50° field of view — 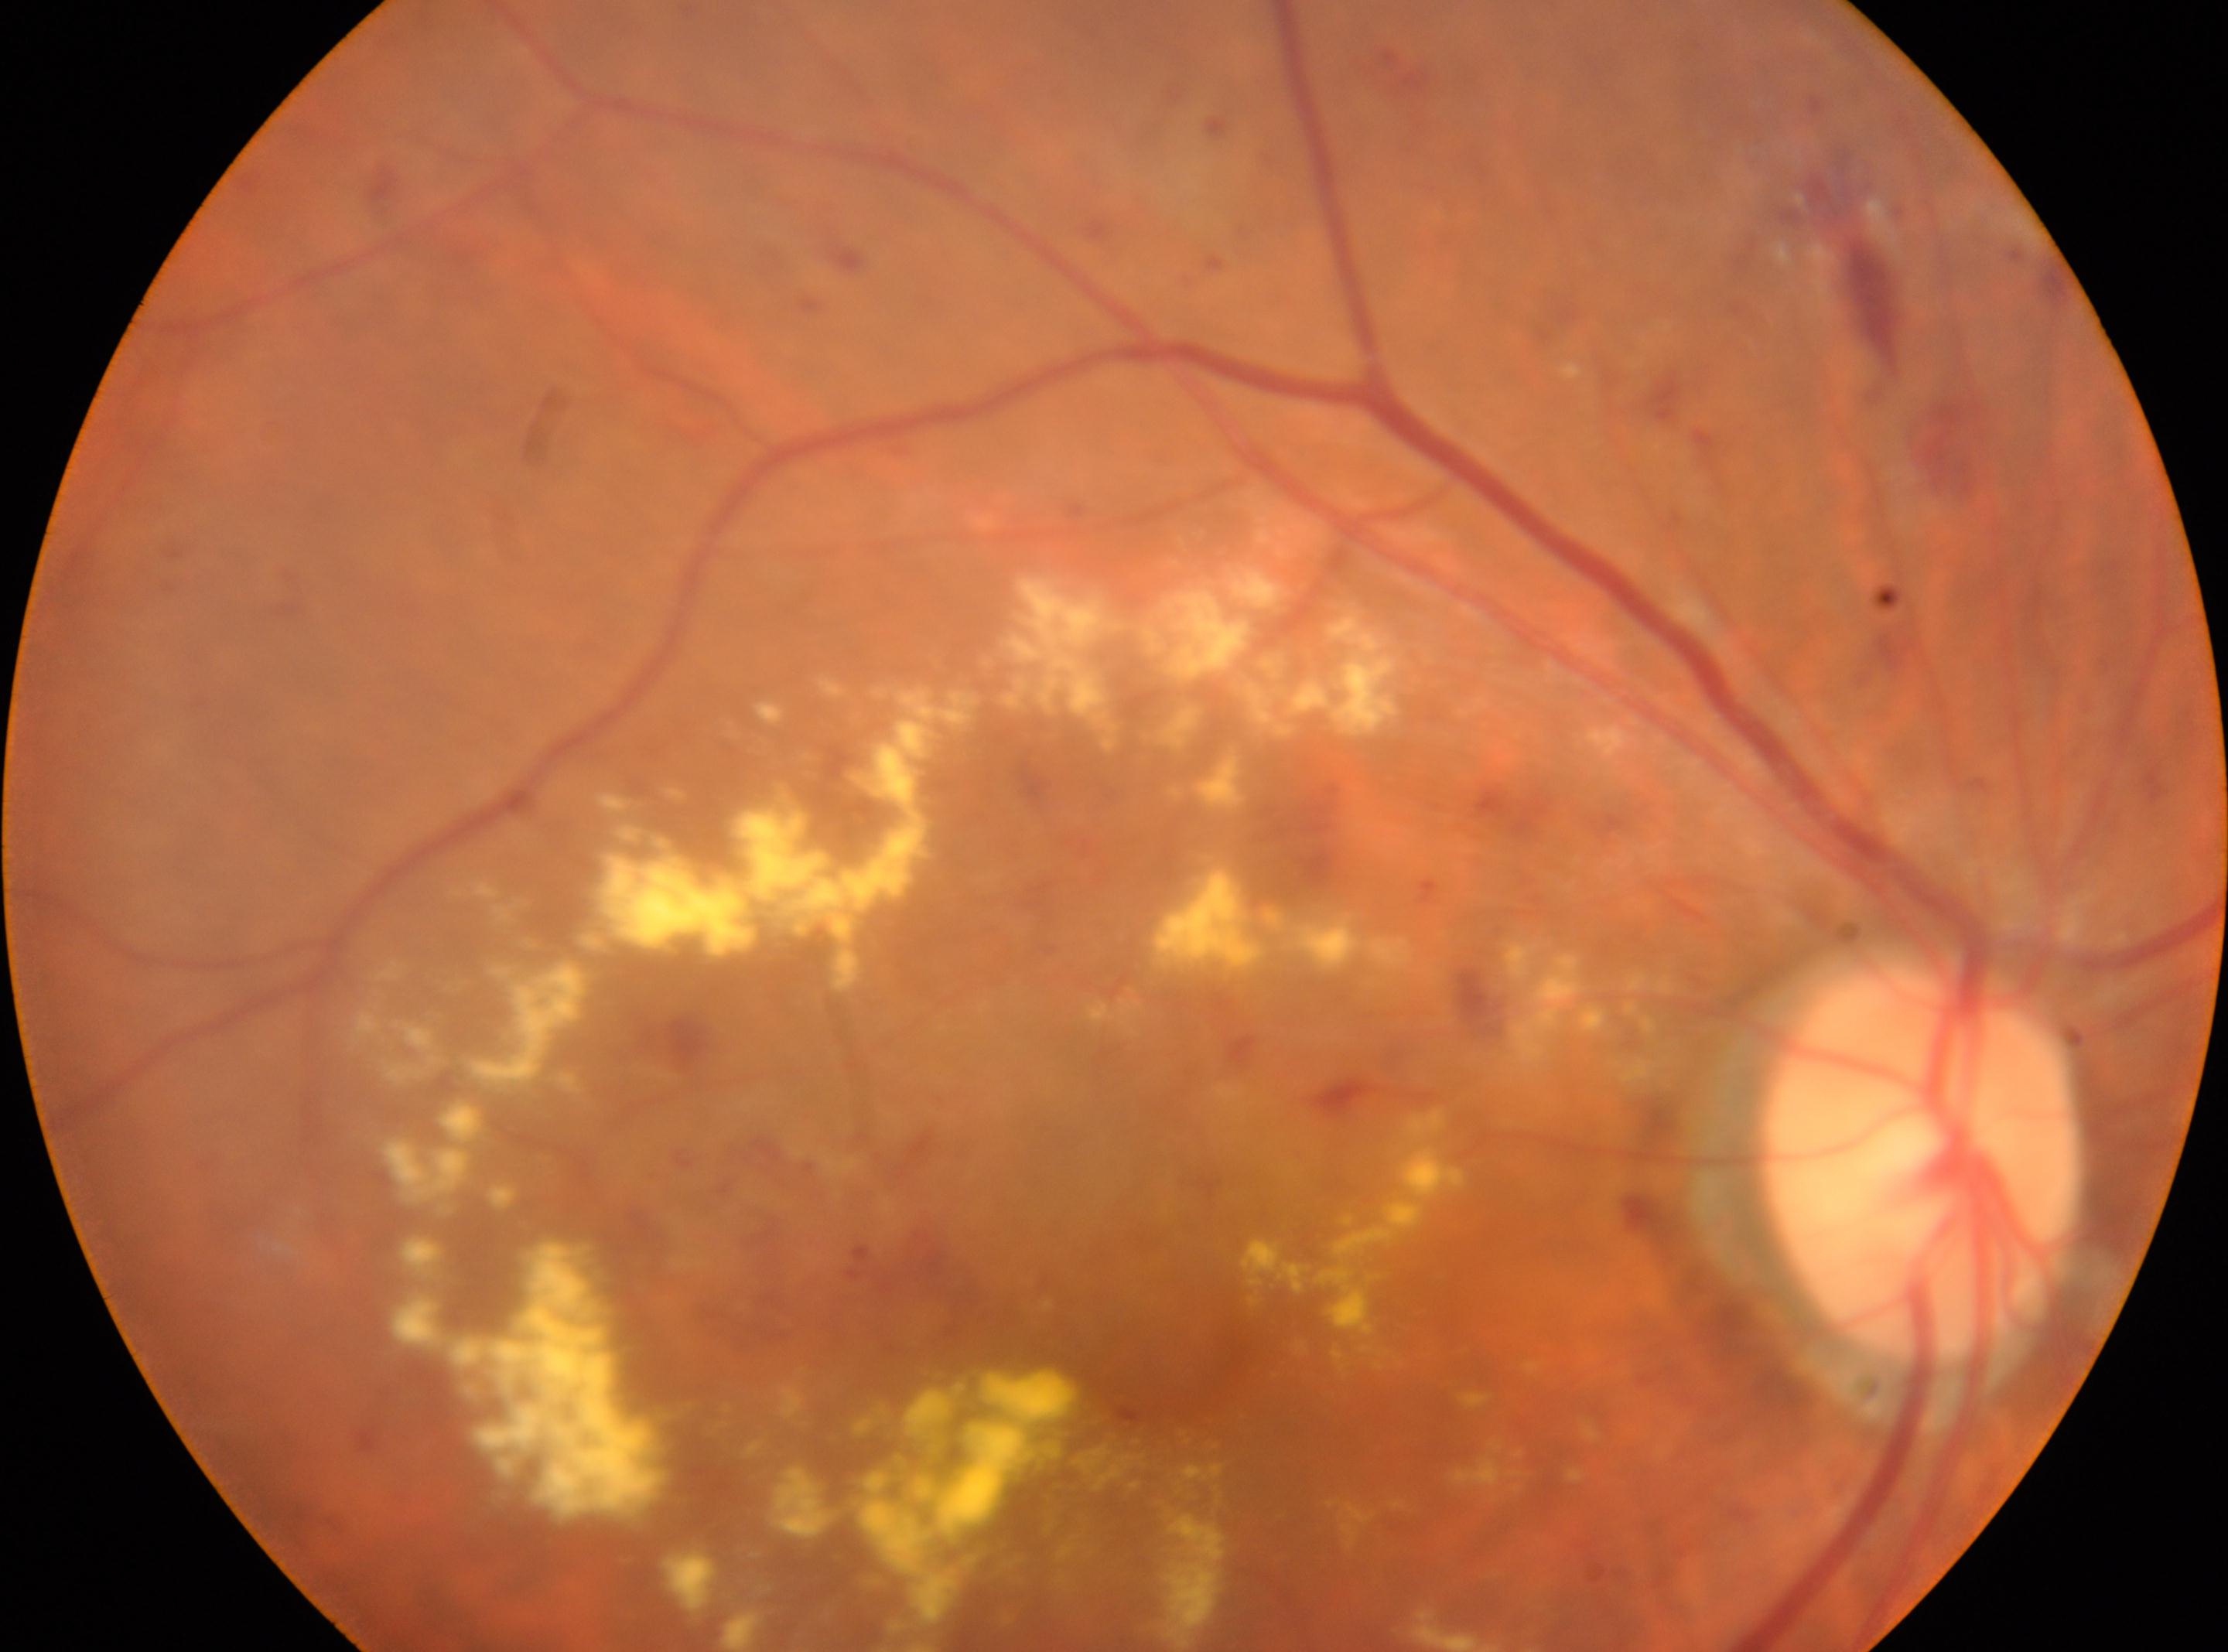

Fovea centralis located at (x=1167, y=1364). Optic disc center located at (x=1922, y=1162). Retinopathy: grade 2 (moderate NPDR). Eye: right.